Image size 2361x1568 · dilated-pupil acquisition — 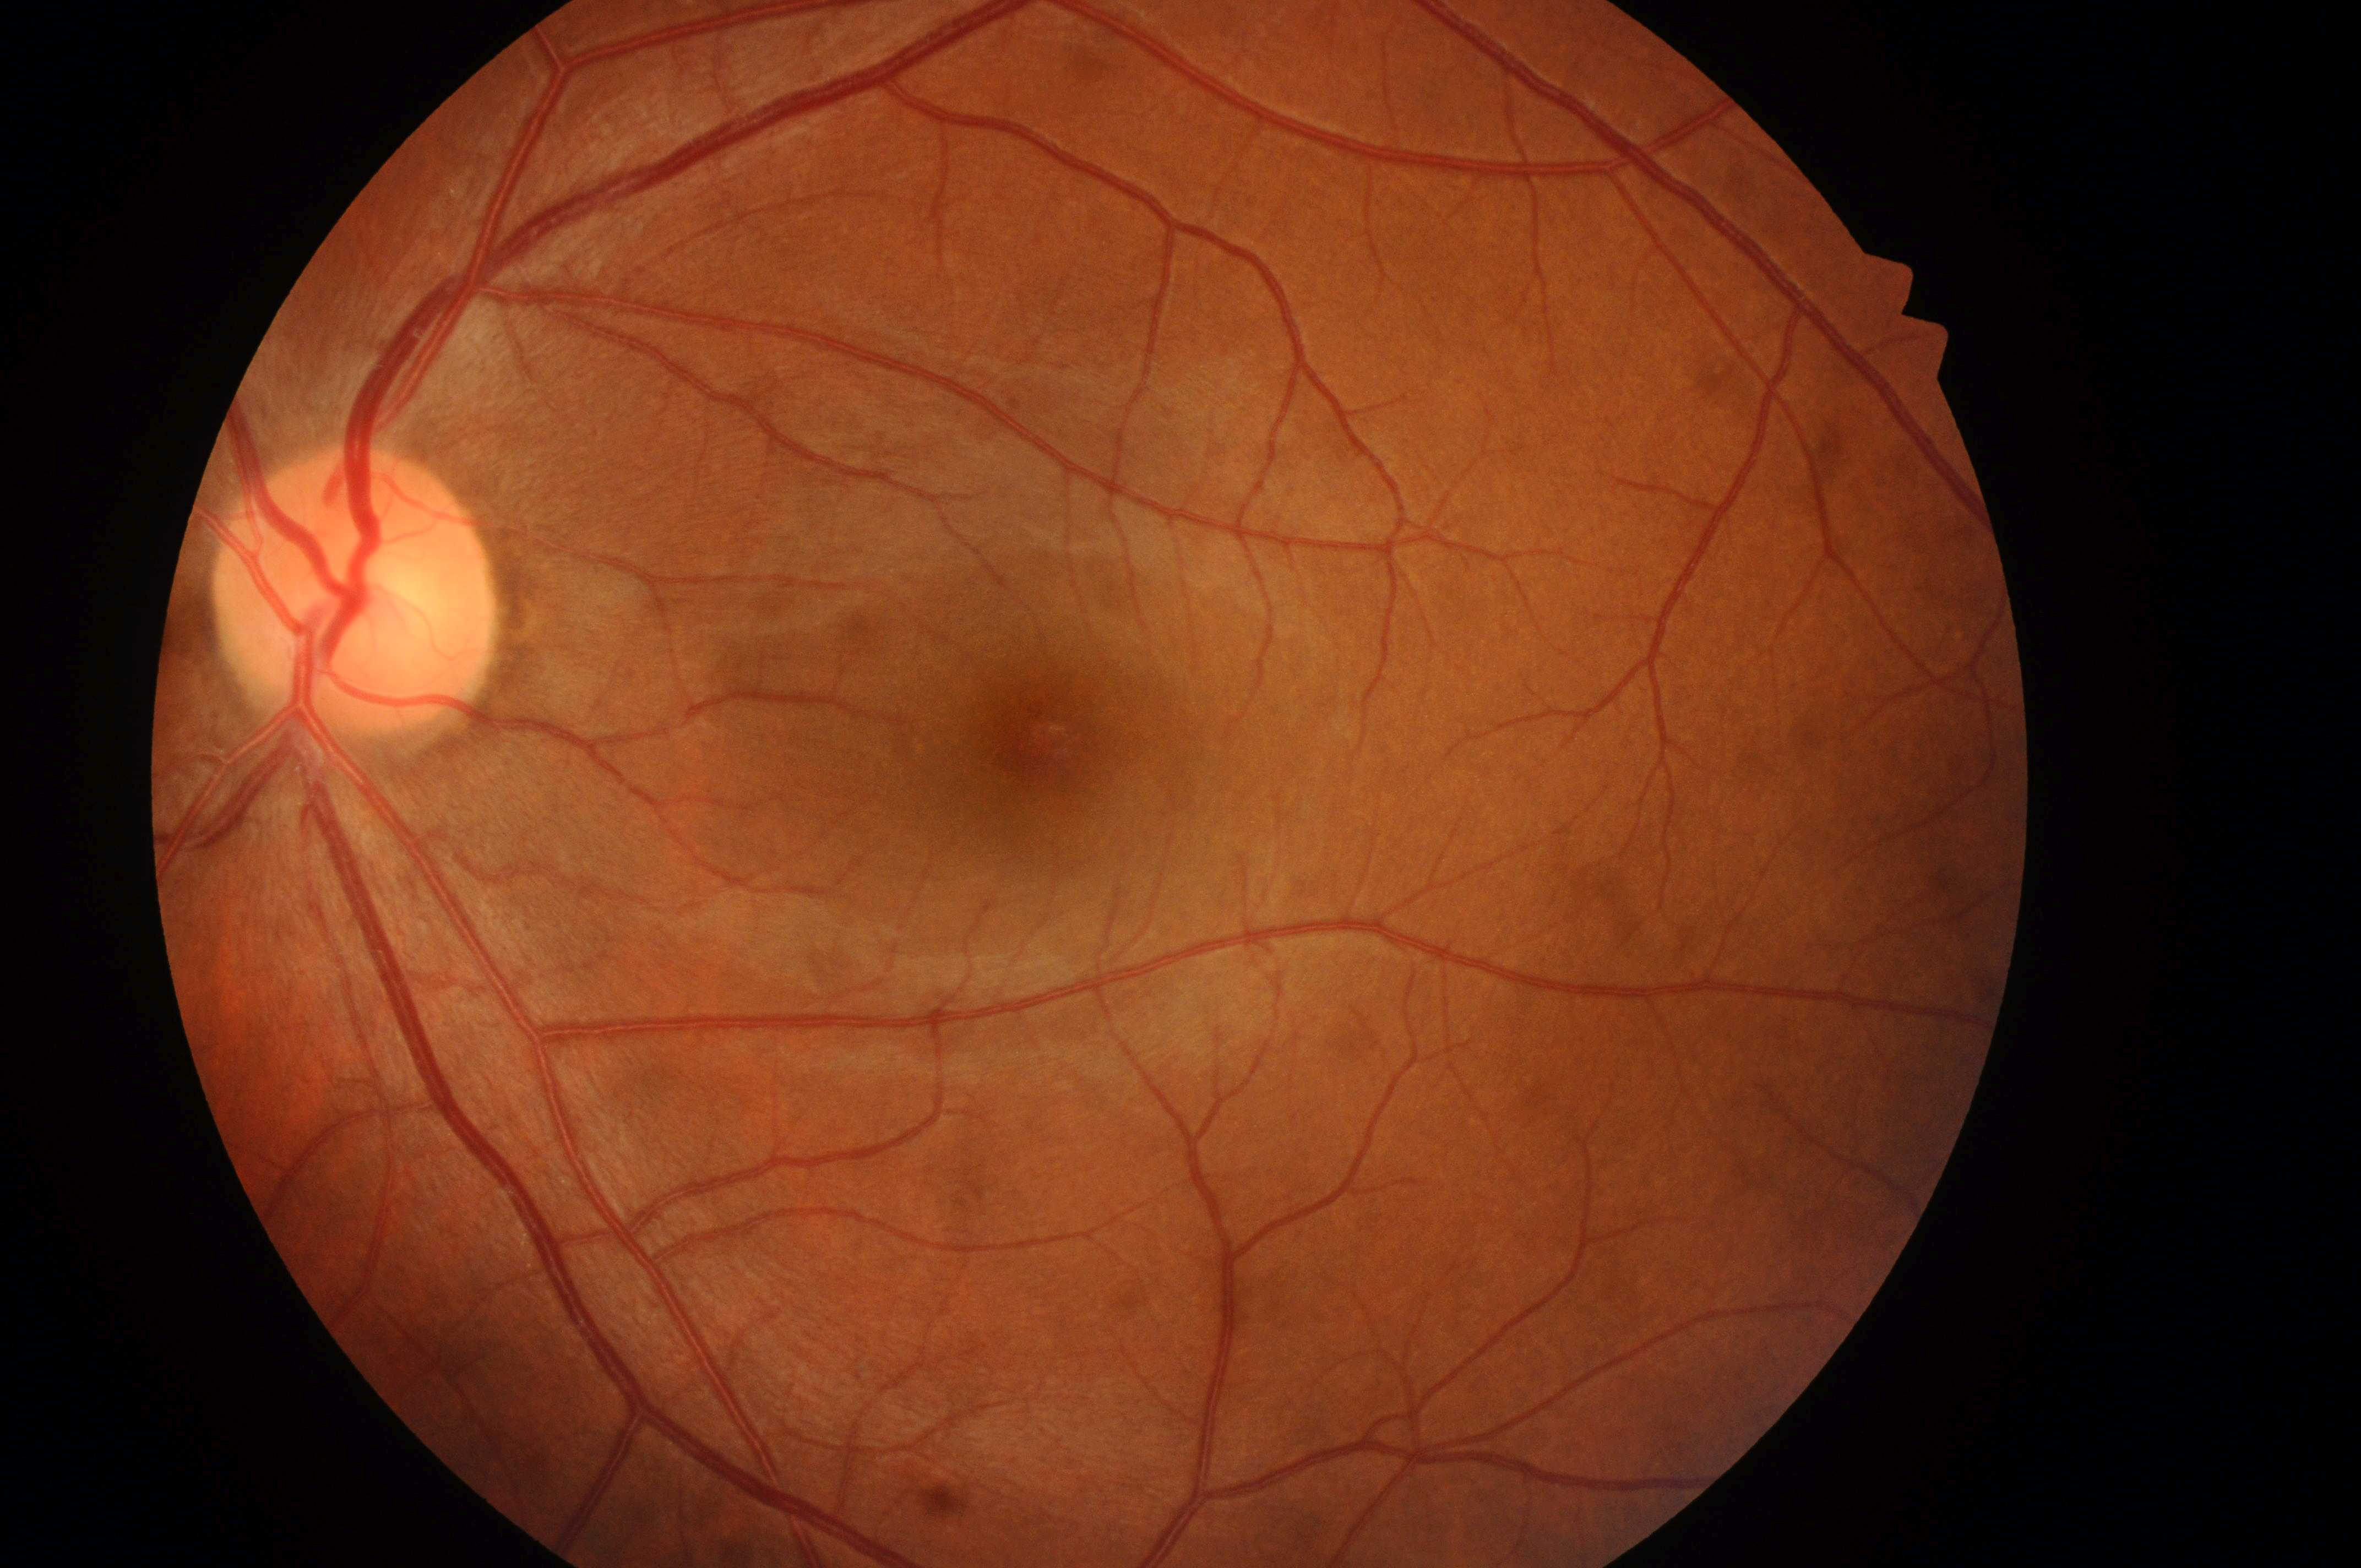

DME risk = grade 0 (no risk)
DR severity = grade 0 (no apparent retinopathy)
macula center = (x: 1042, y: 742)
optic disk = (x: 348, y: 608)
eye = OS